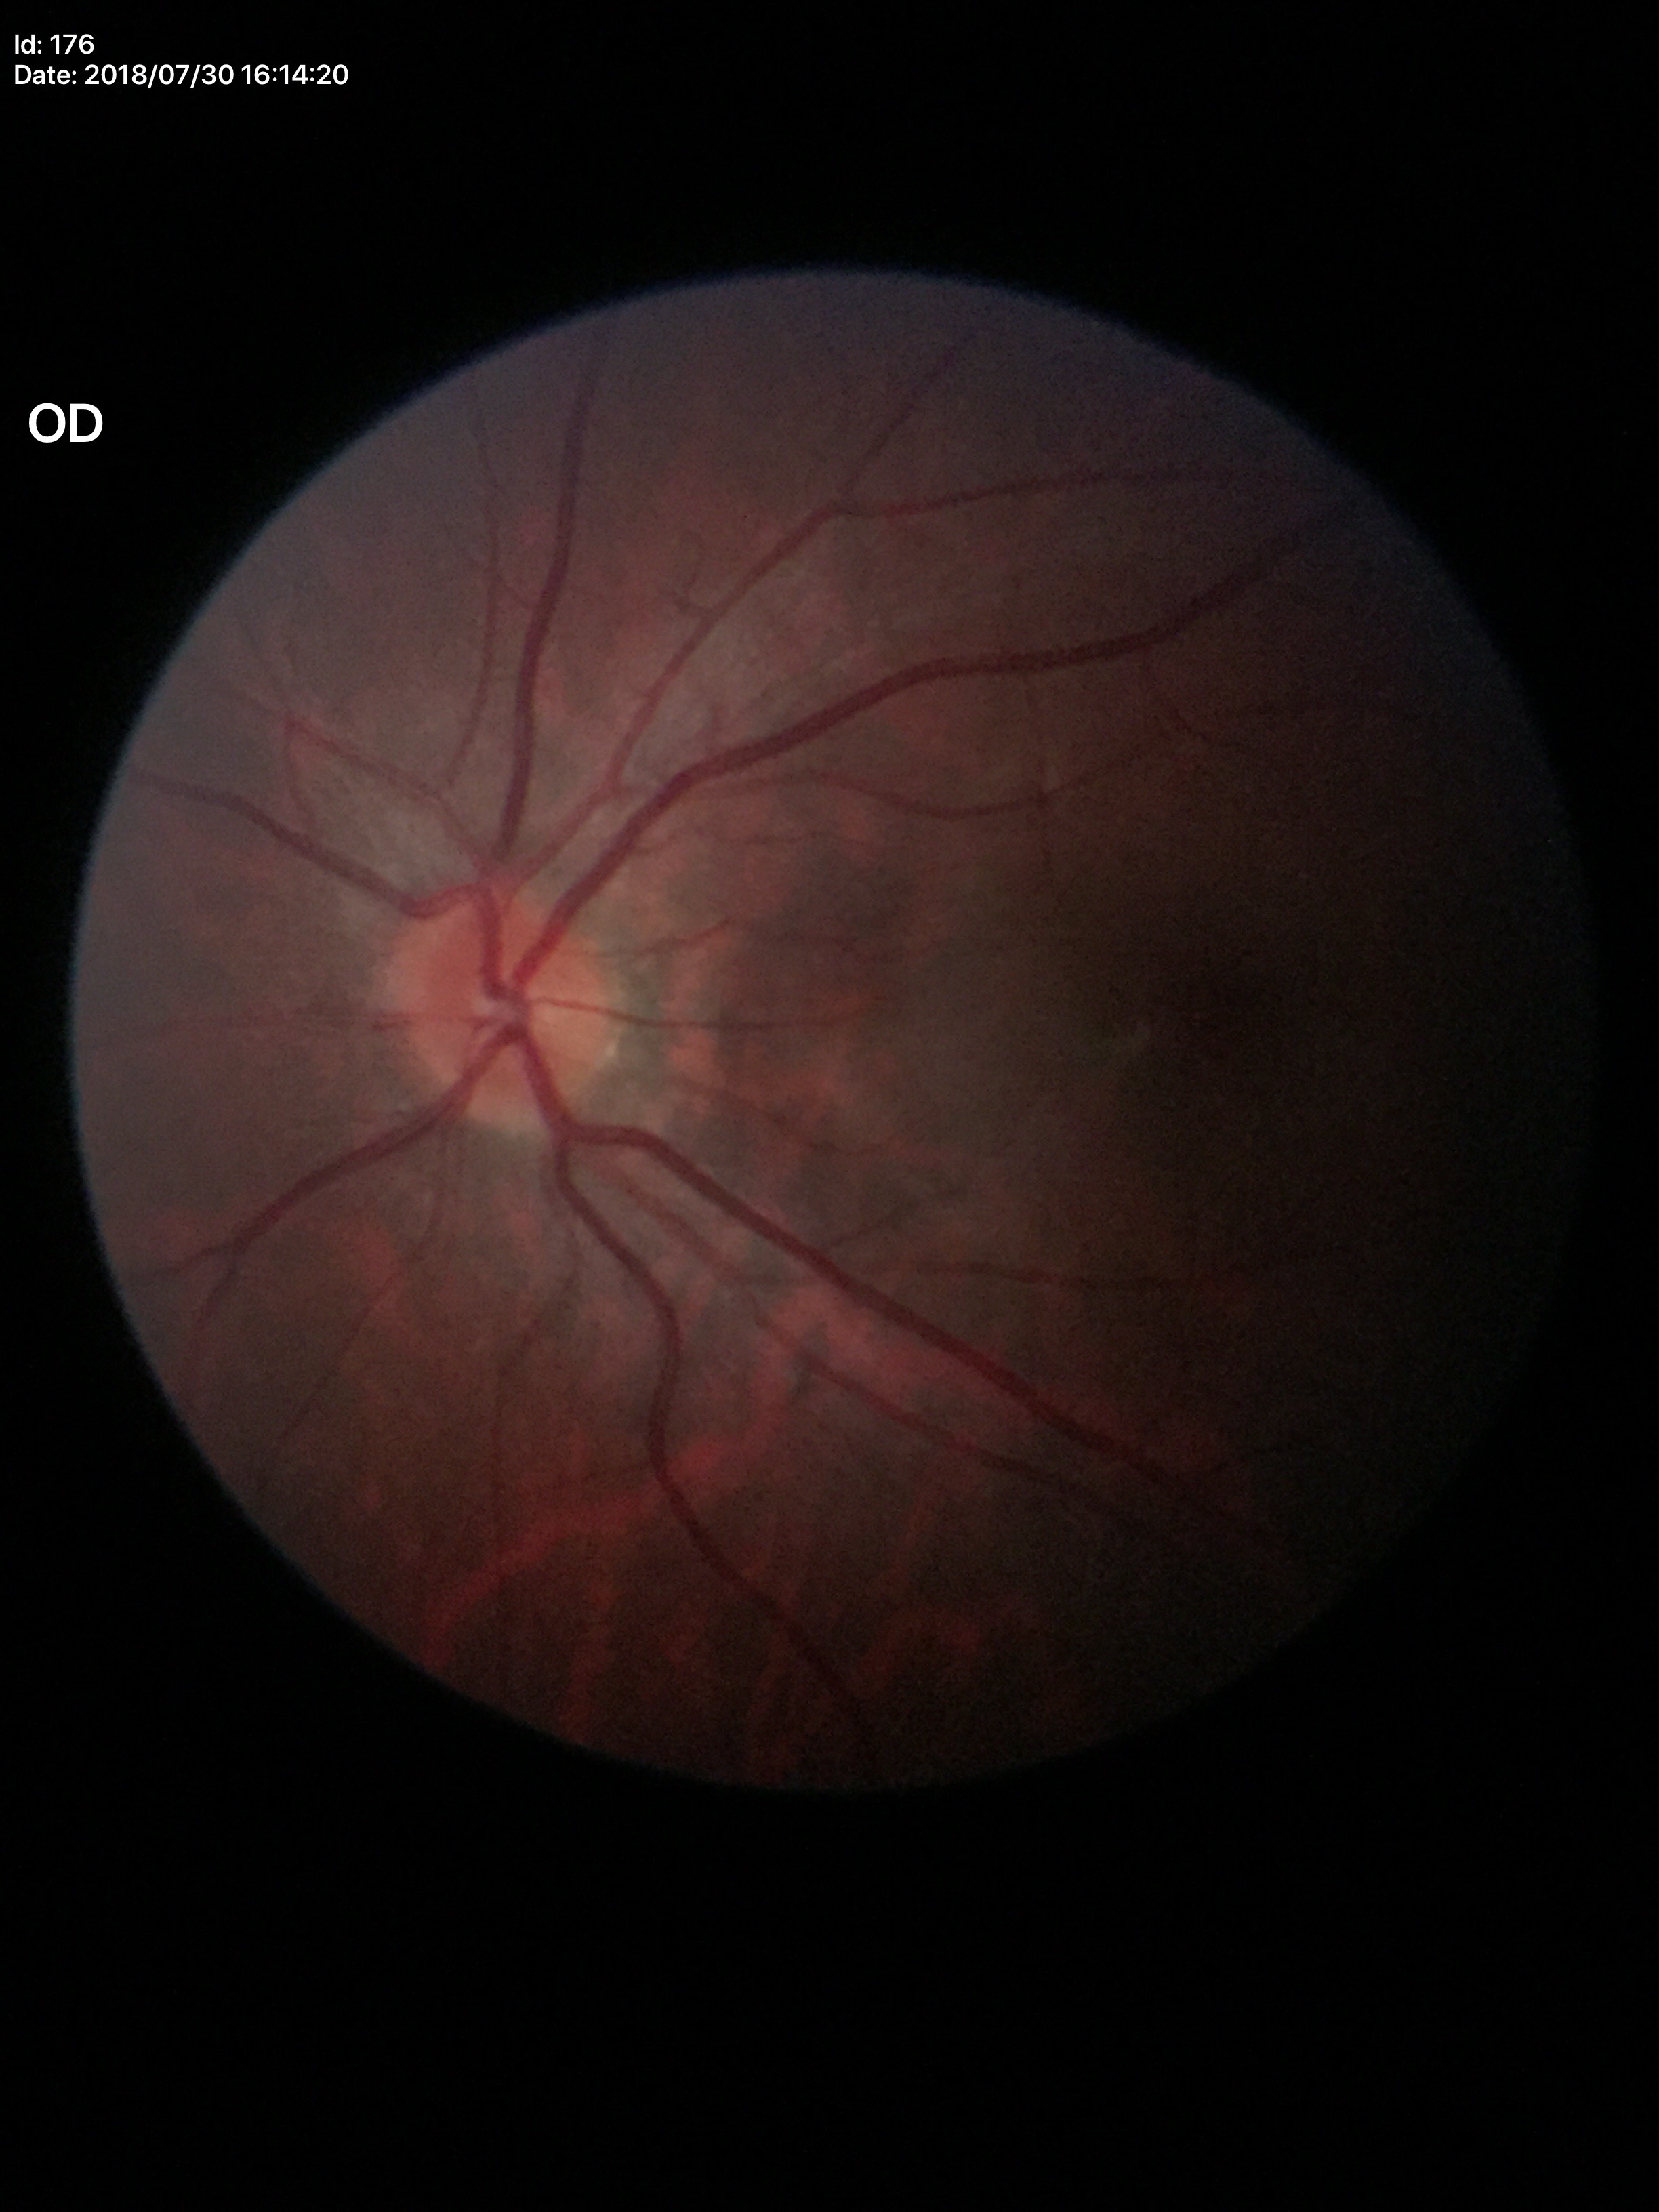 Negative for glaucoma suspicion.
Vertical CDR: 0.39.
Area C/D ratio: 0.16.